100° field of view (Phoenix ICON); infant wide-field fundus photograph; 1240 by 1240 pixels — 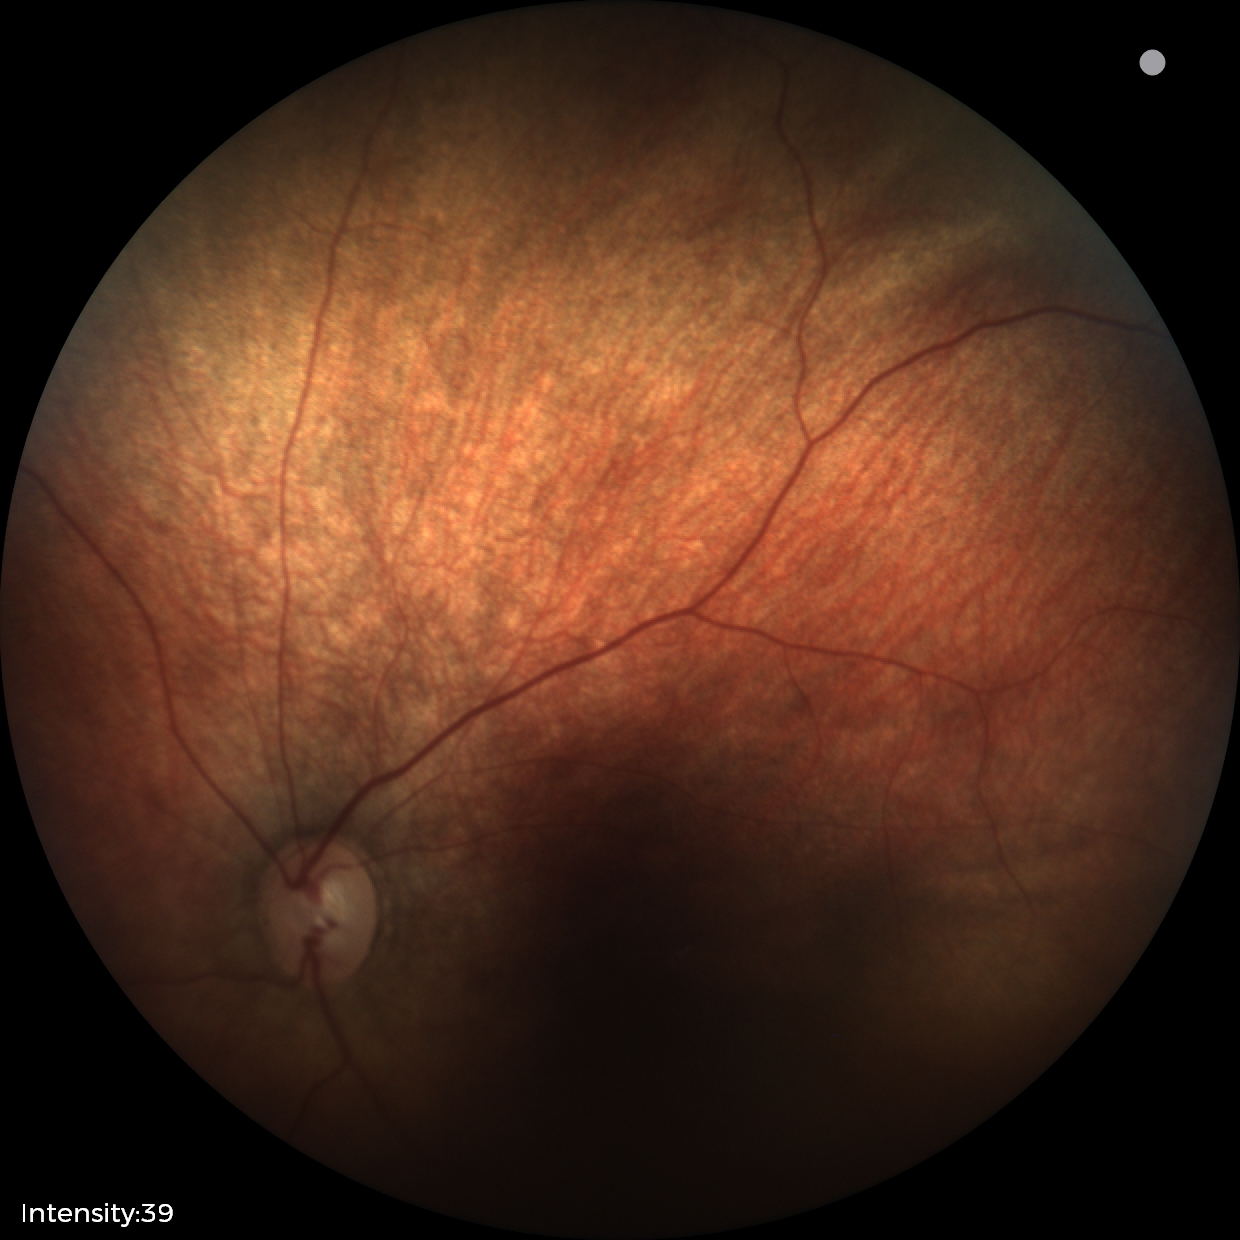 Normal screening examination.